Fundus photo, 512 by 512 pixels — 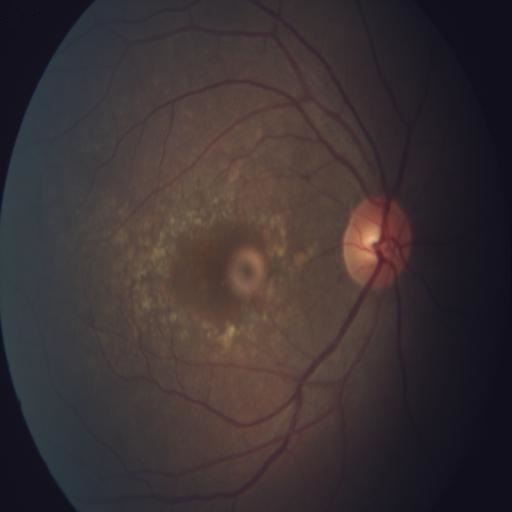

There is evidence of age-related macular degeneration.